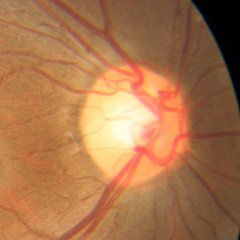
Q: What stage of glaucoma is present?
A: No — no signs of glaucoma.